45° field of view; fundus photo; image size 2352x1568: 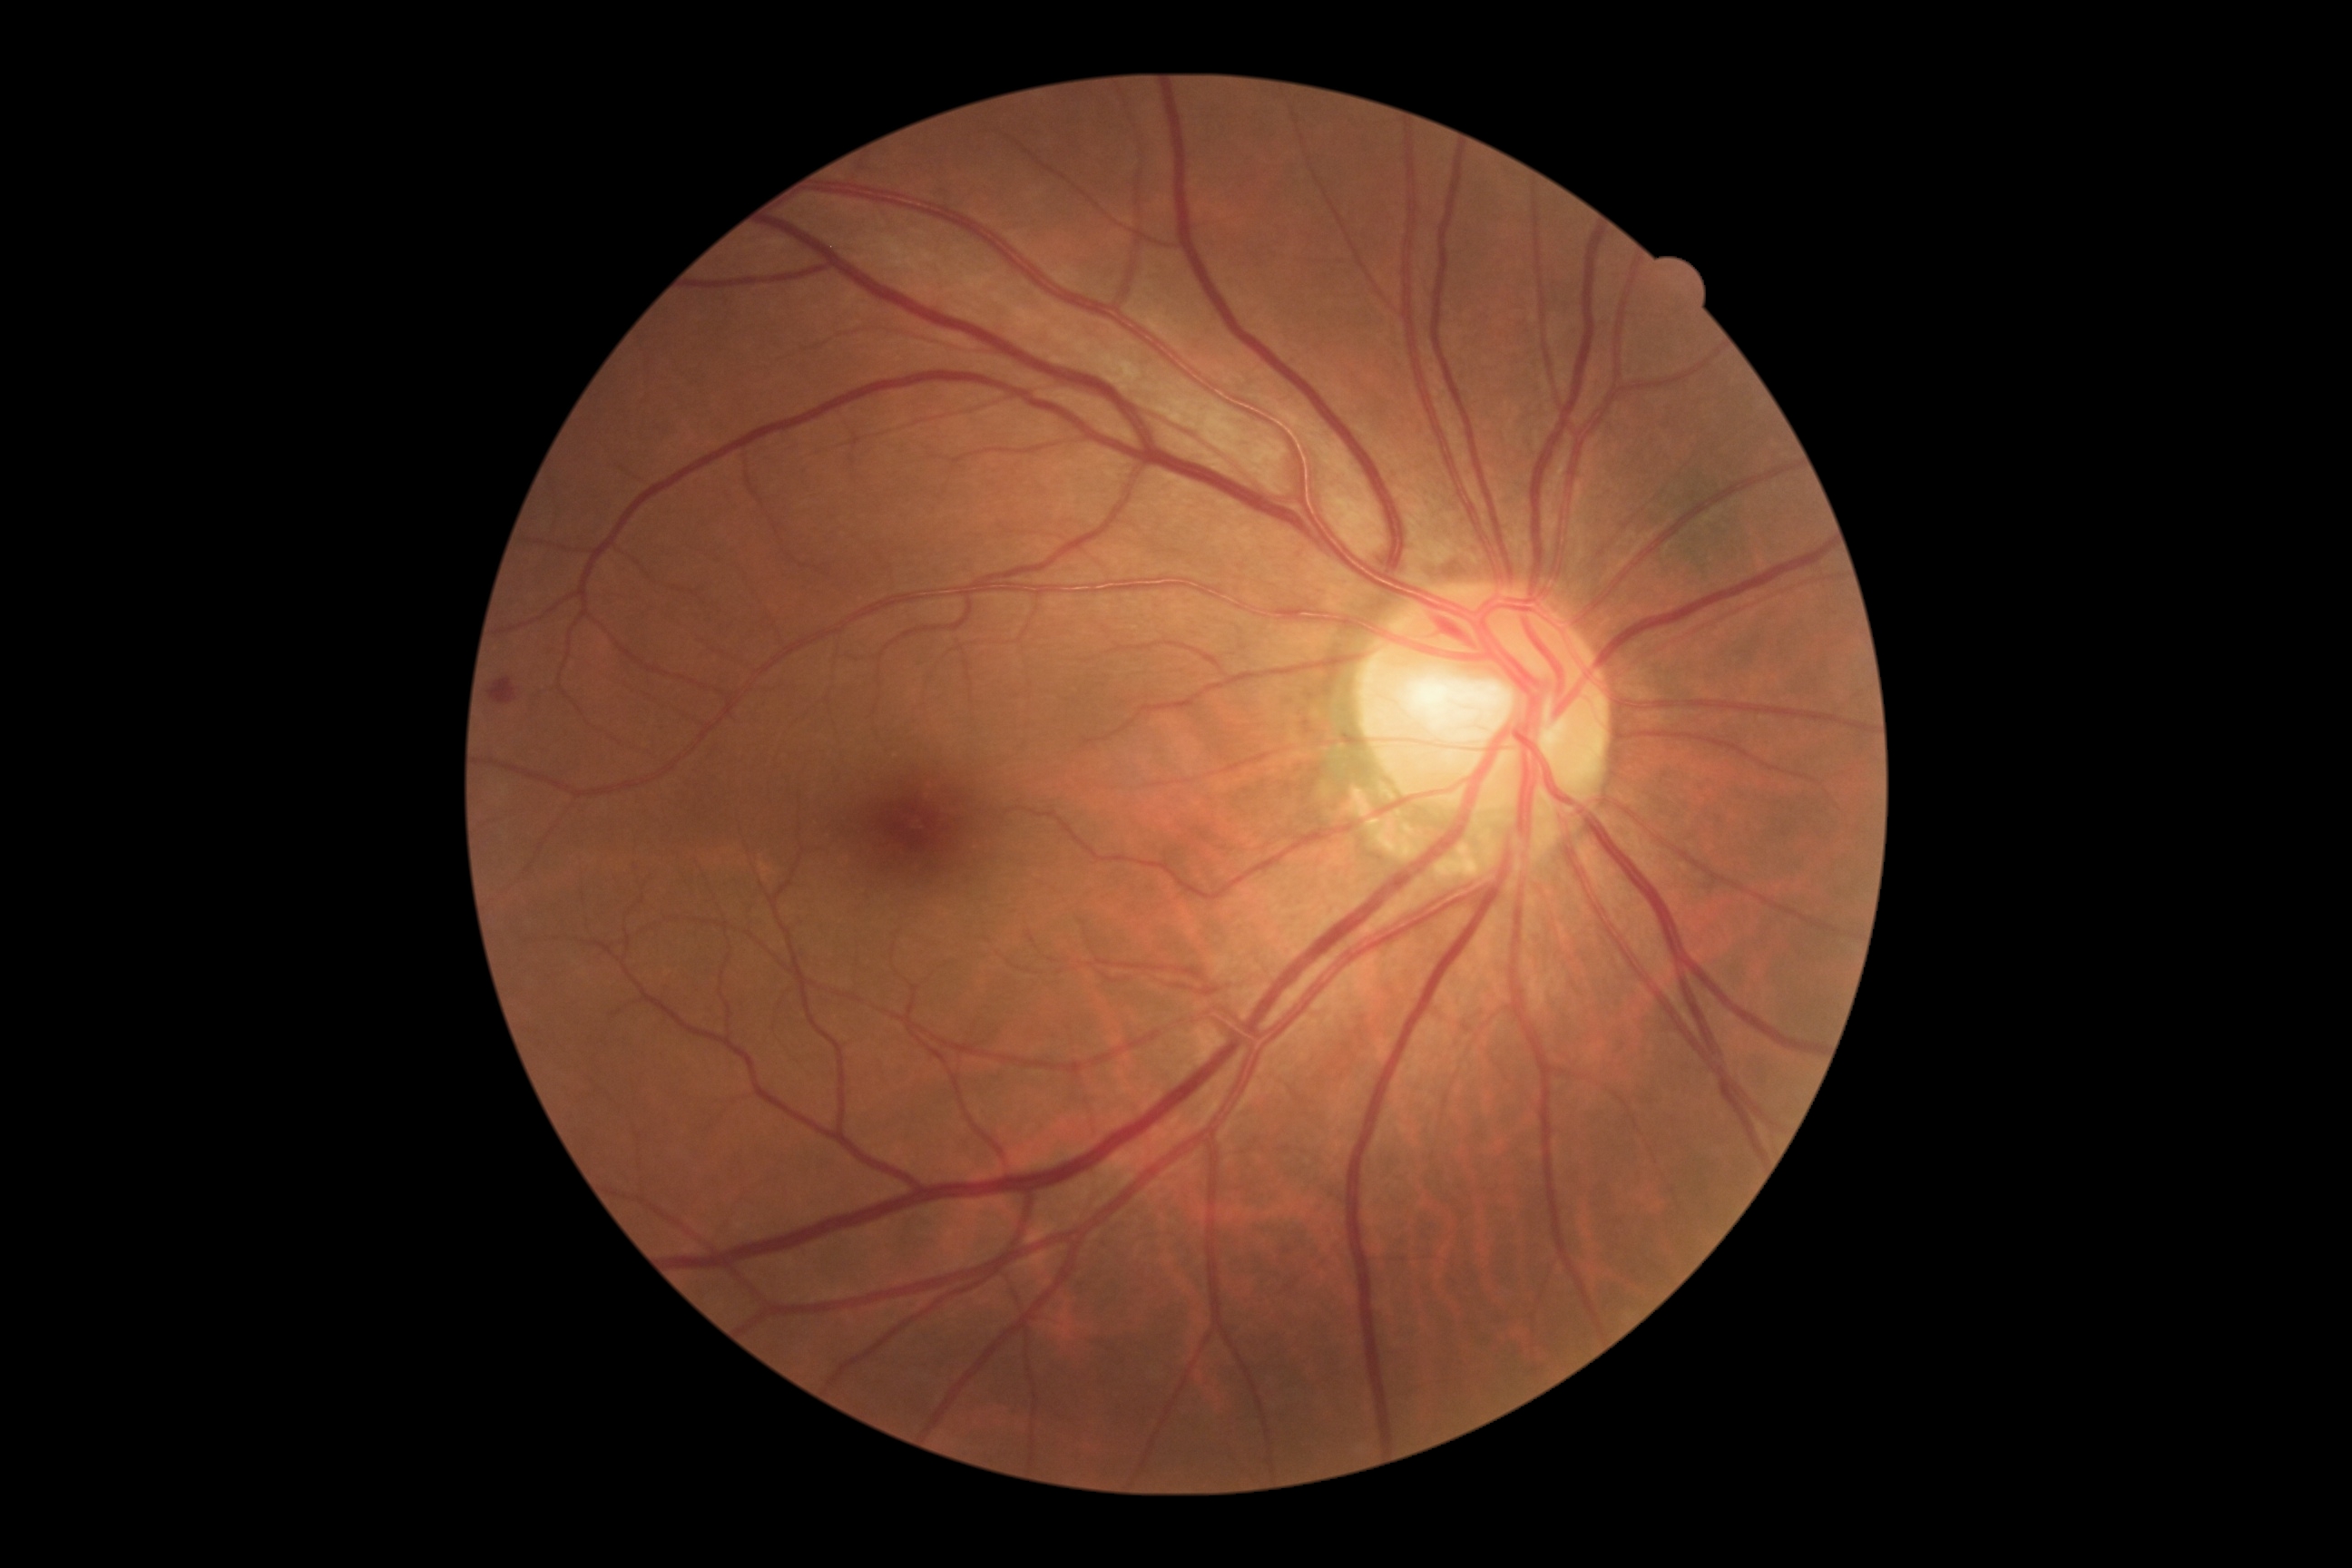 Diabetic retinopathy (DR): 2 — more than just microaneurysms but less than severe NPDR
microaneurysms (MAs): none
soft exudates (SEs): none
hard exudates (EXs): none
hemorrhages (HEs): 487 678 516 705